Image size 2352x1568 · fundus photo · 45-degree field of view.
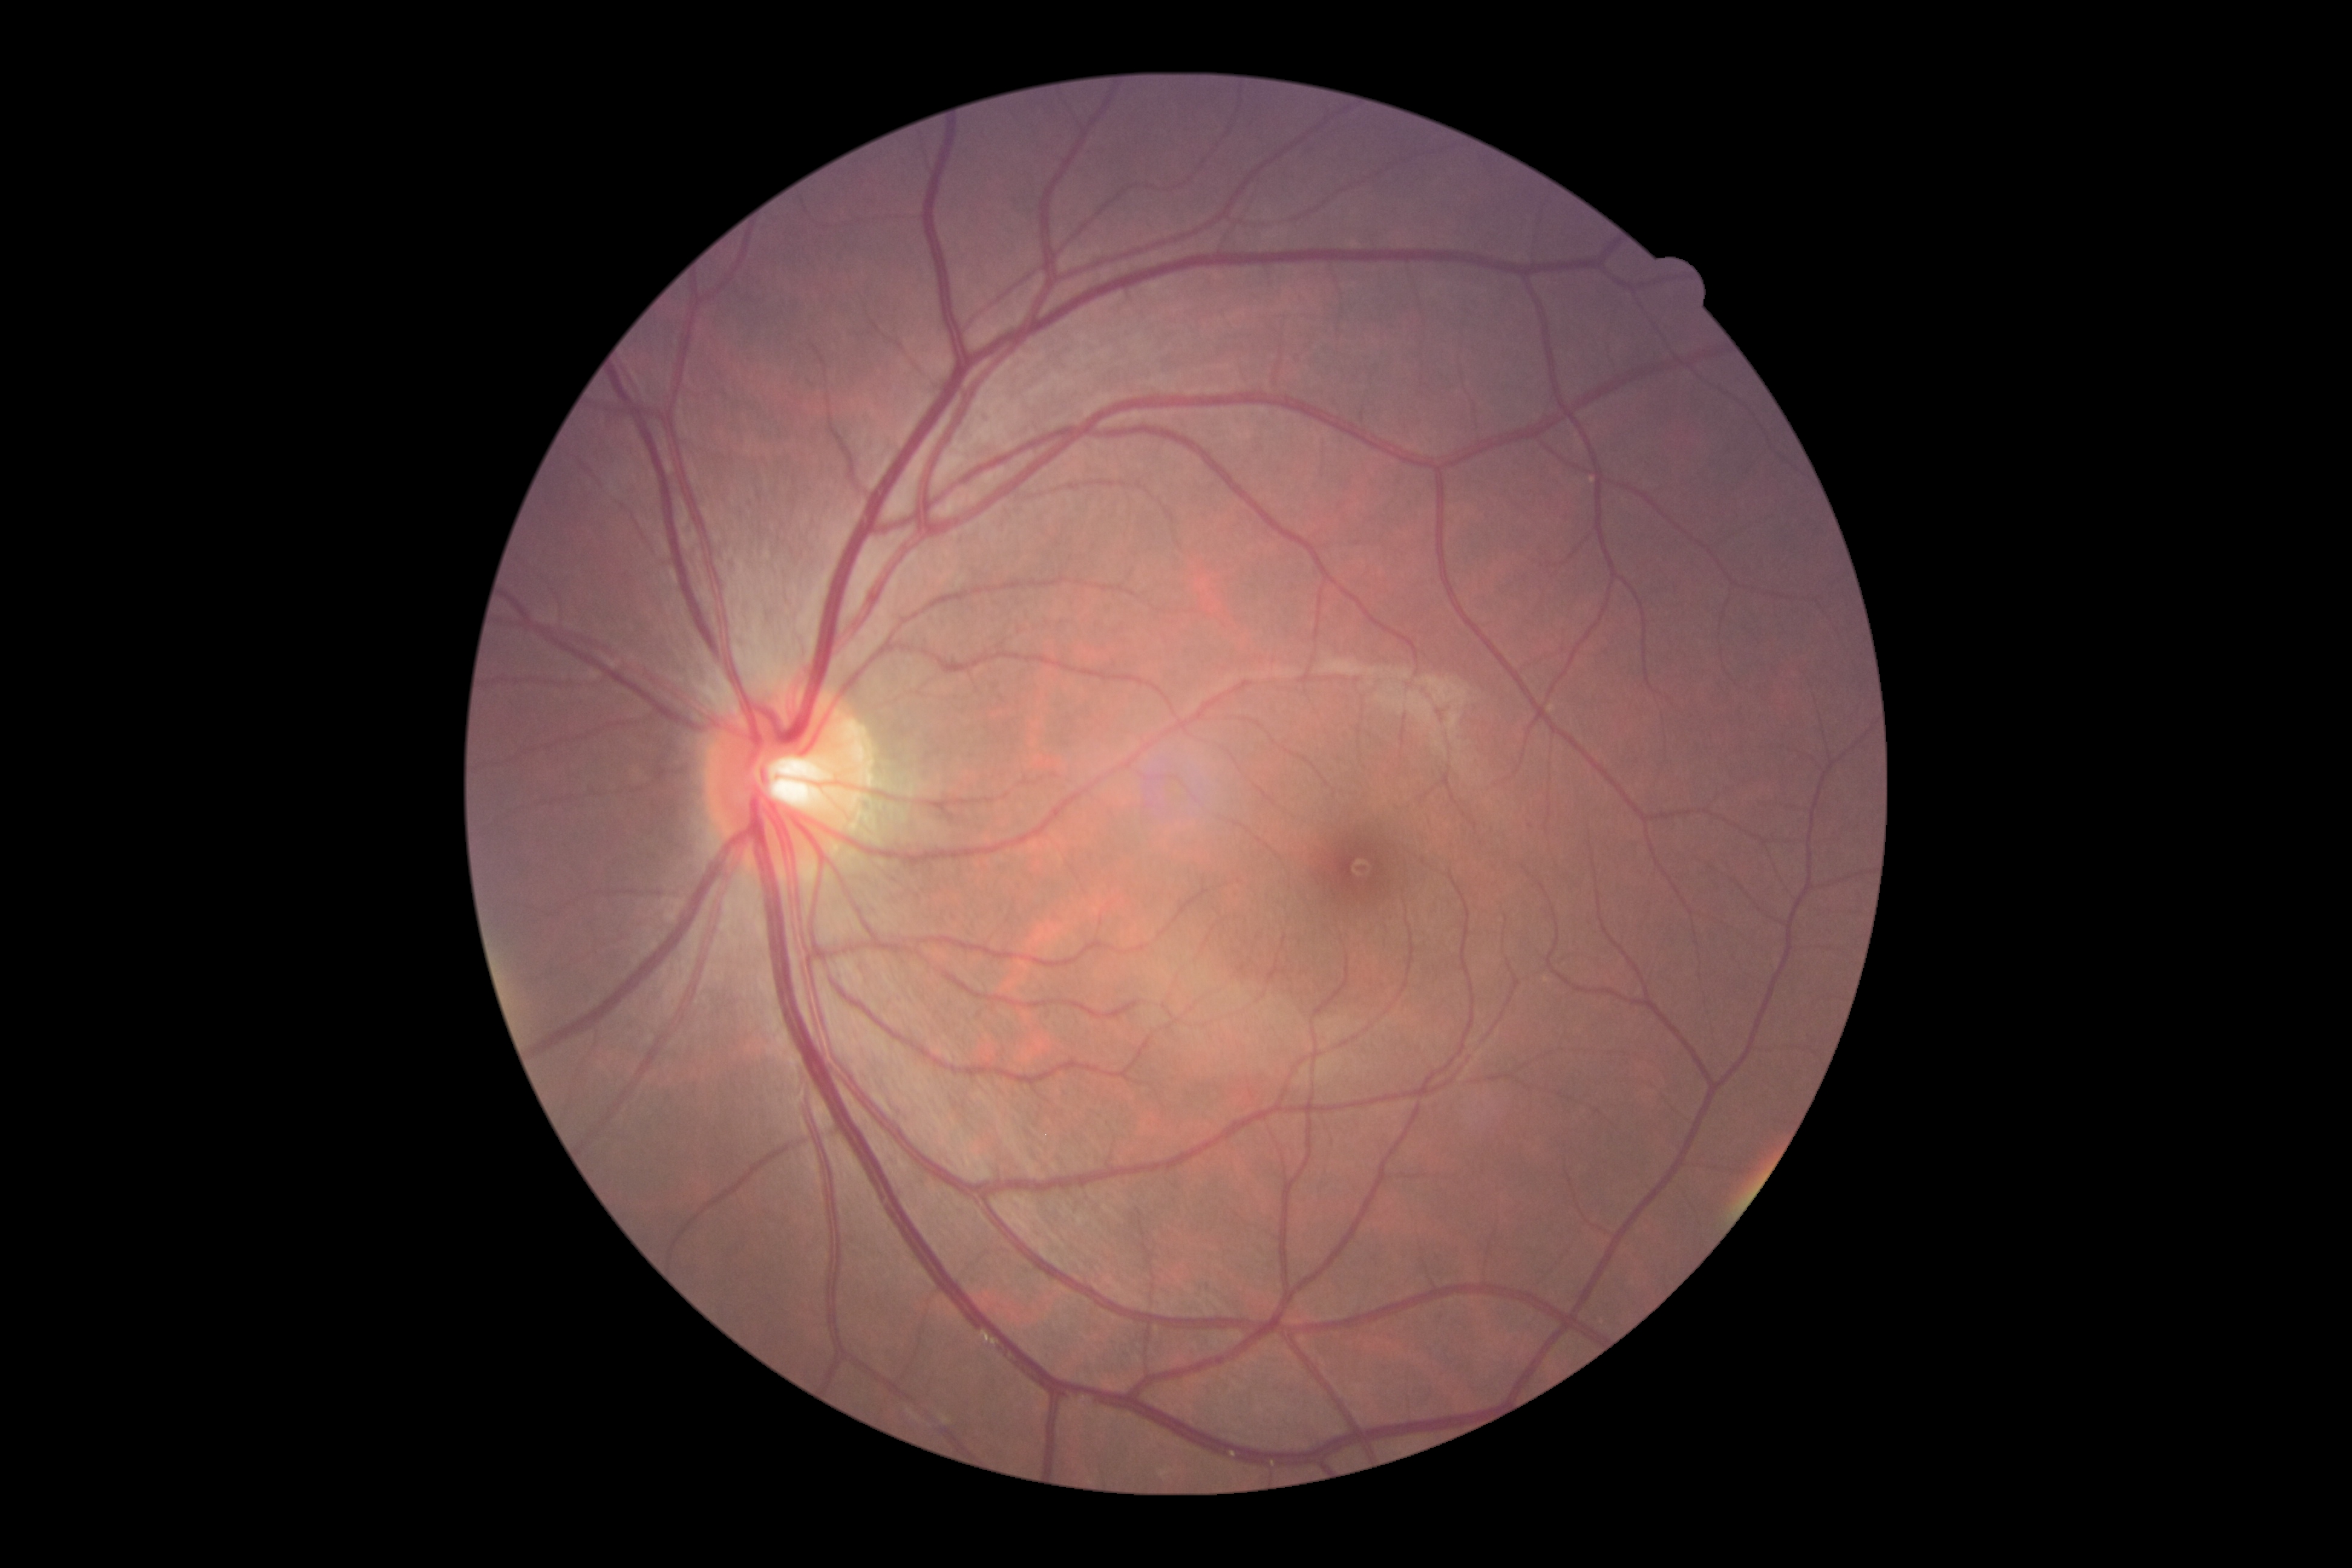
{"dr_impression": "no signs of DR", "dr_grade": "no apparent diabetic retinopathy (grade 0)"}